Camera: Natus RetCam Envision (130° FOV); wide-field fundus photograph of an infant; 1440 x 1080 pixels:
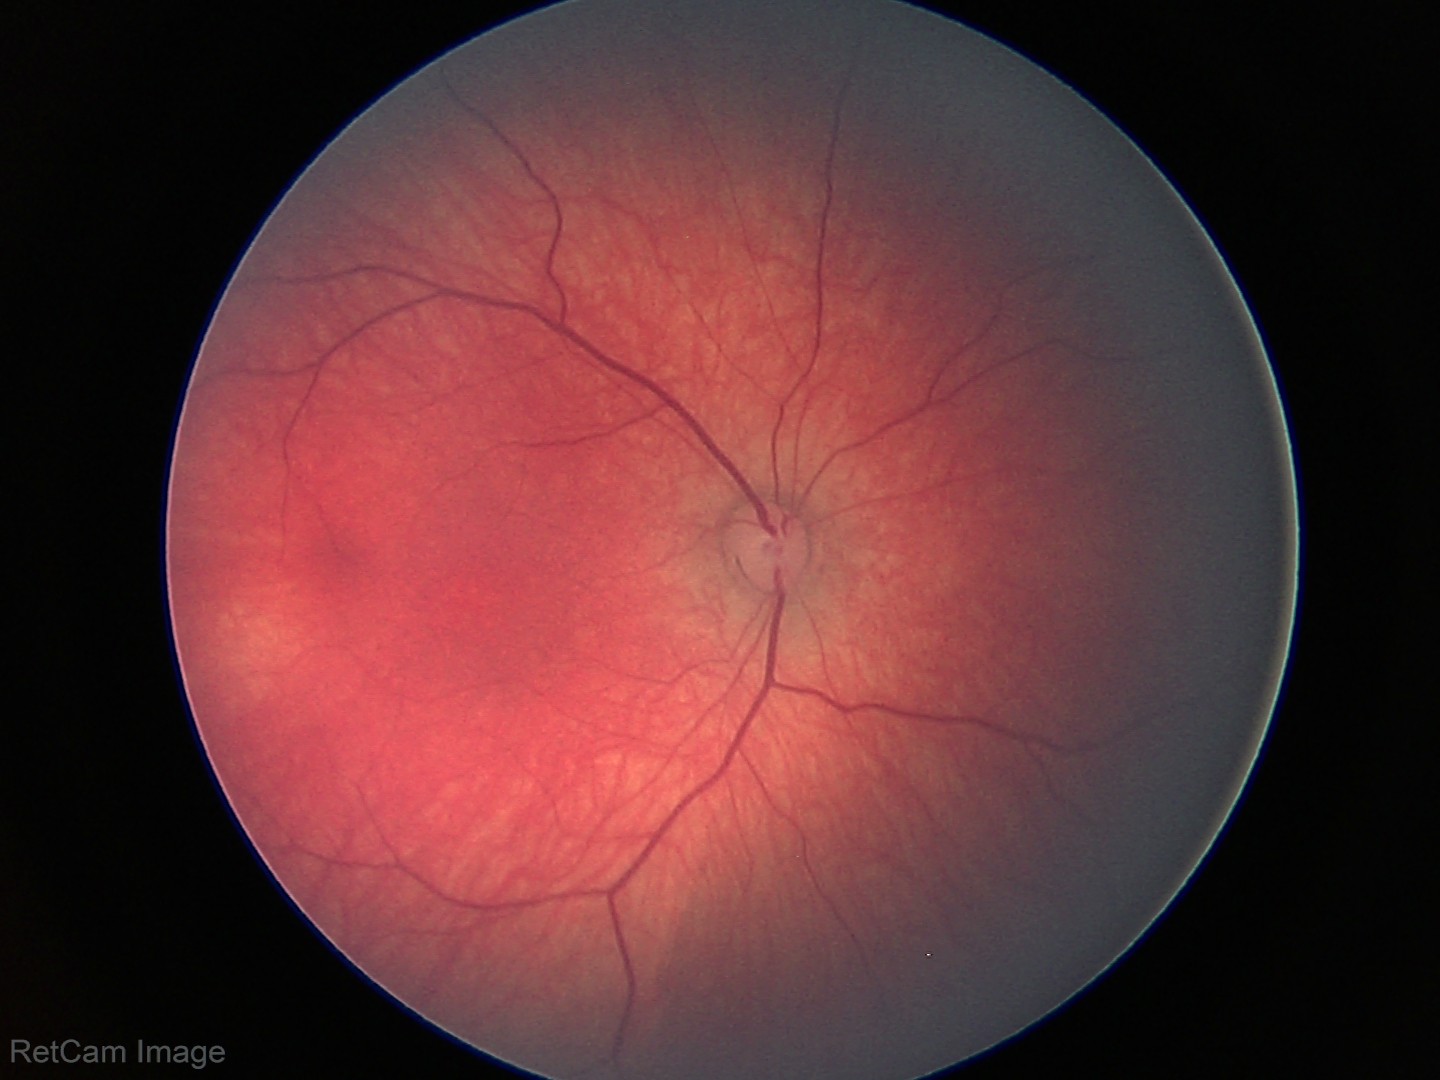
Impression = normal retinal appearance.